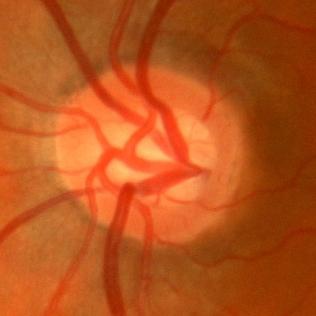

Q: Does this eye have glaucoma?
A: No evidence of glaucoma.